Modified Davis classification.
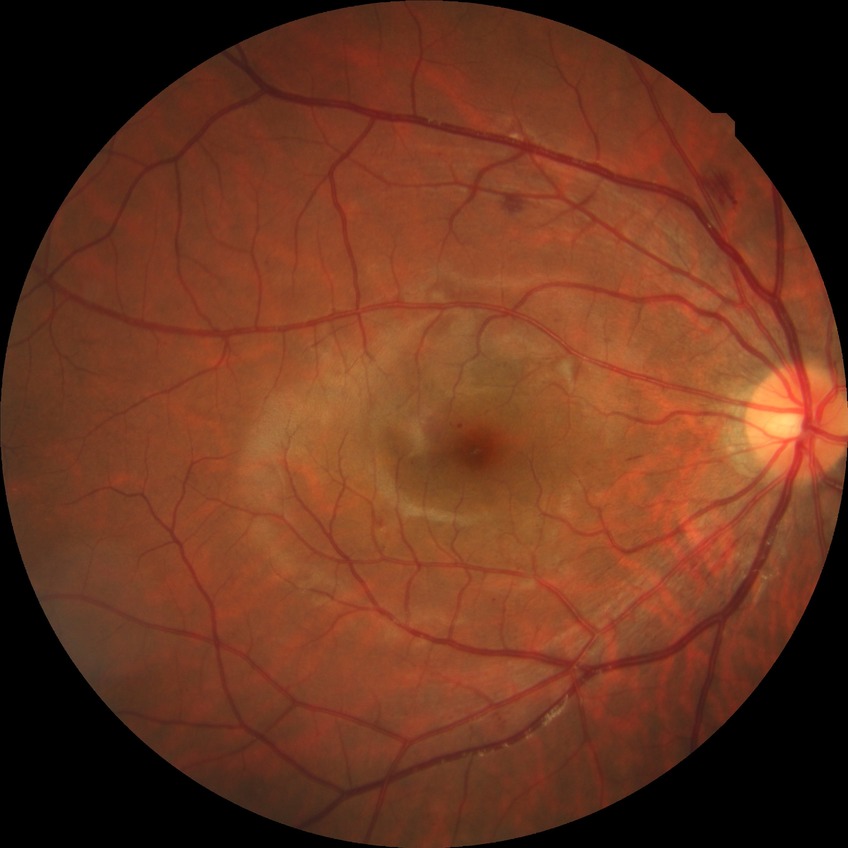
Davis grading is simple diabetic retinopathy.